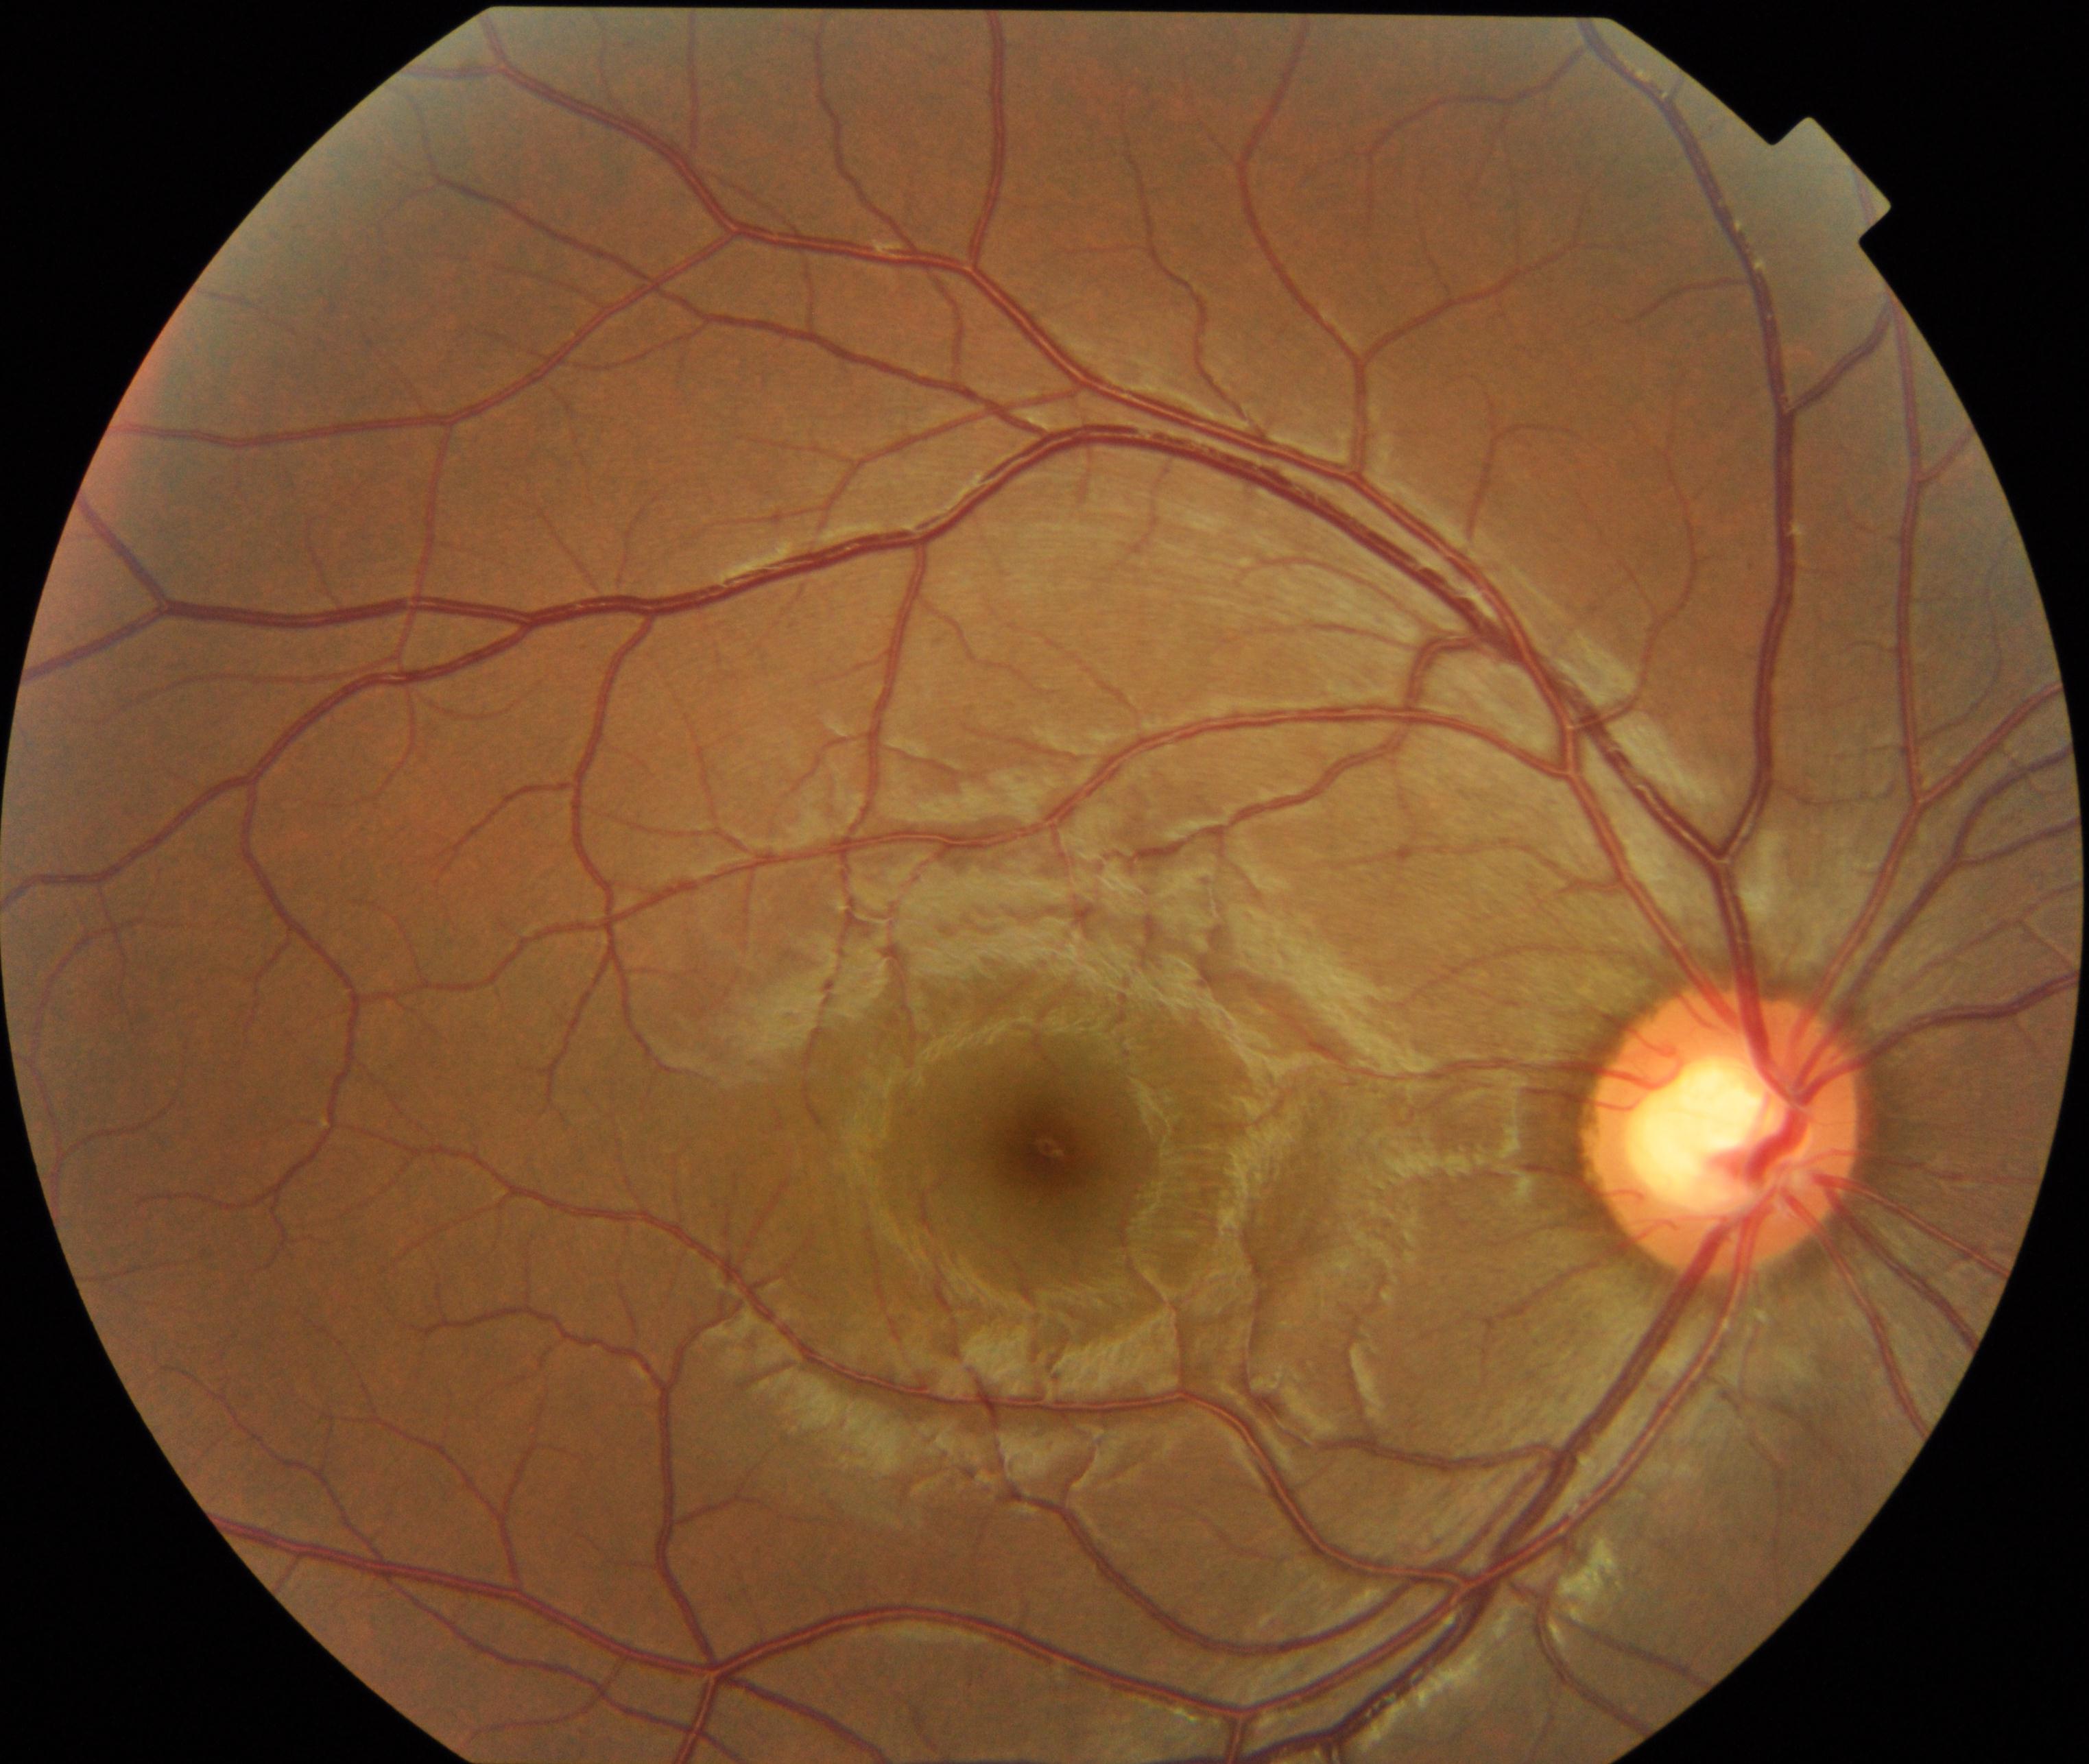

Primary finding: large optic cup.